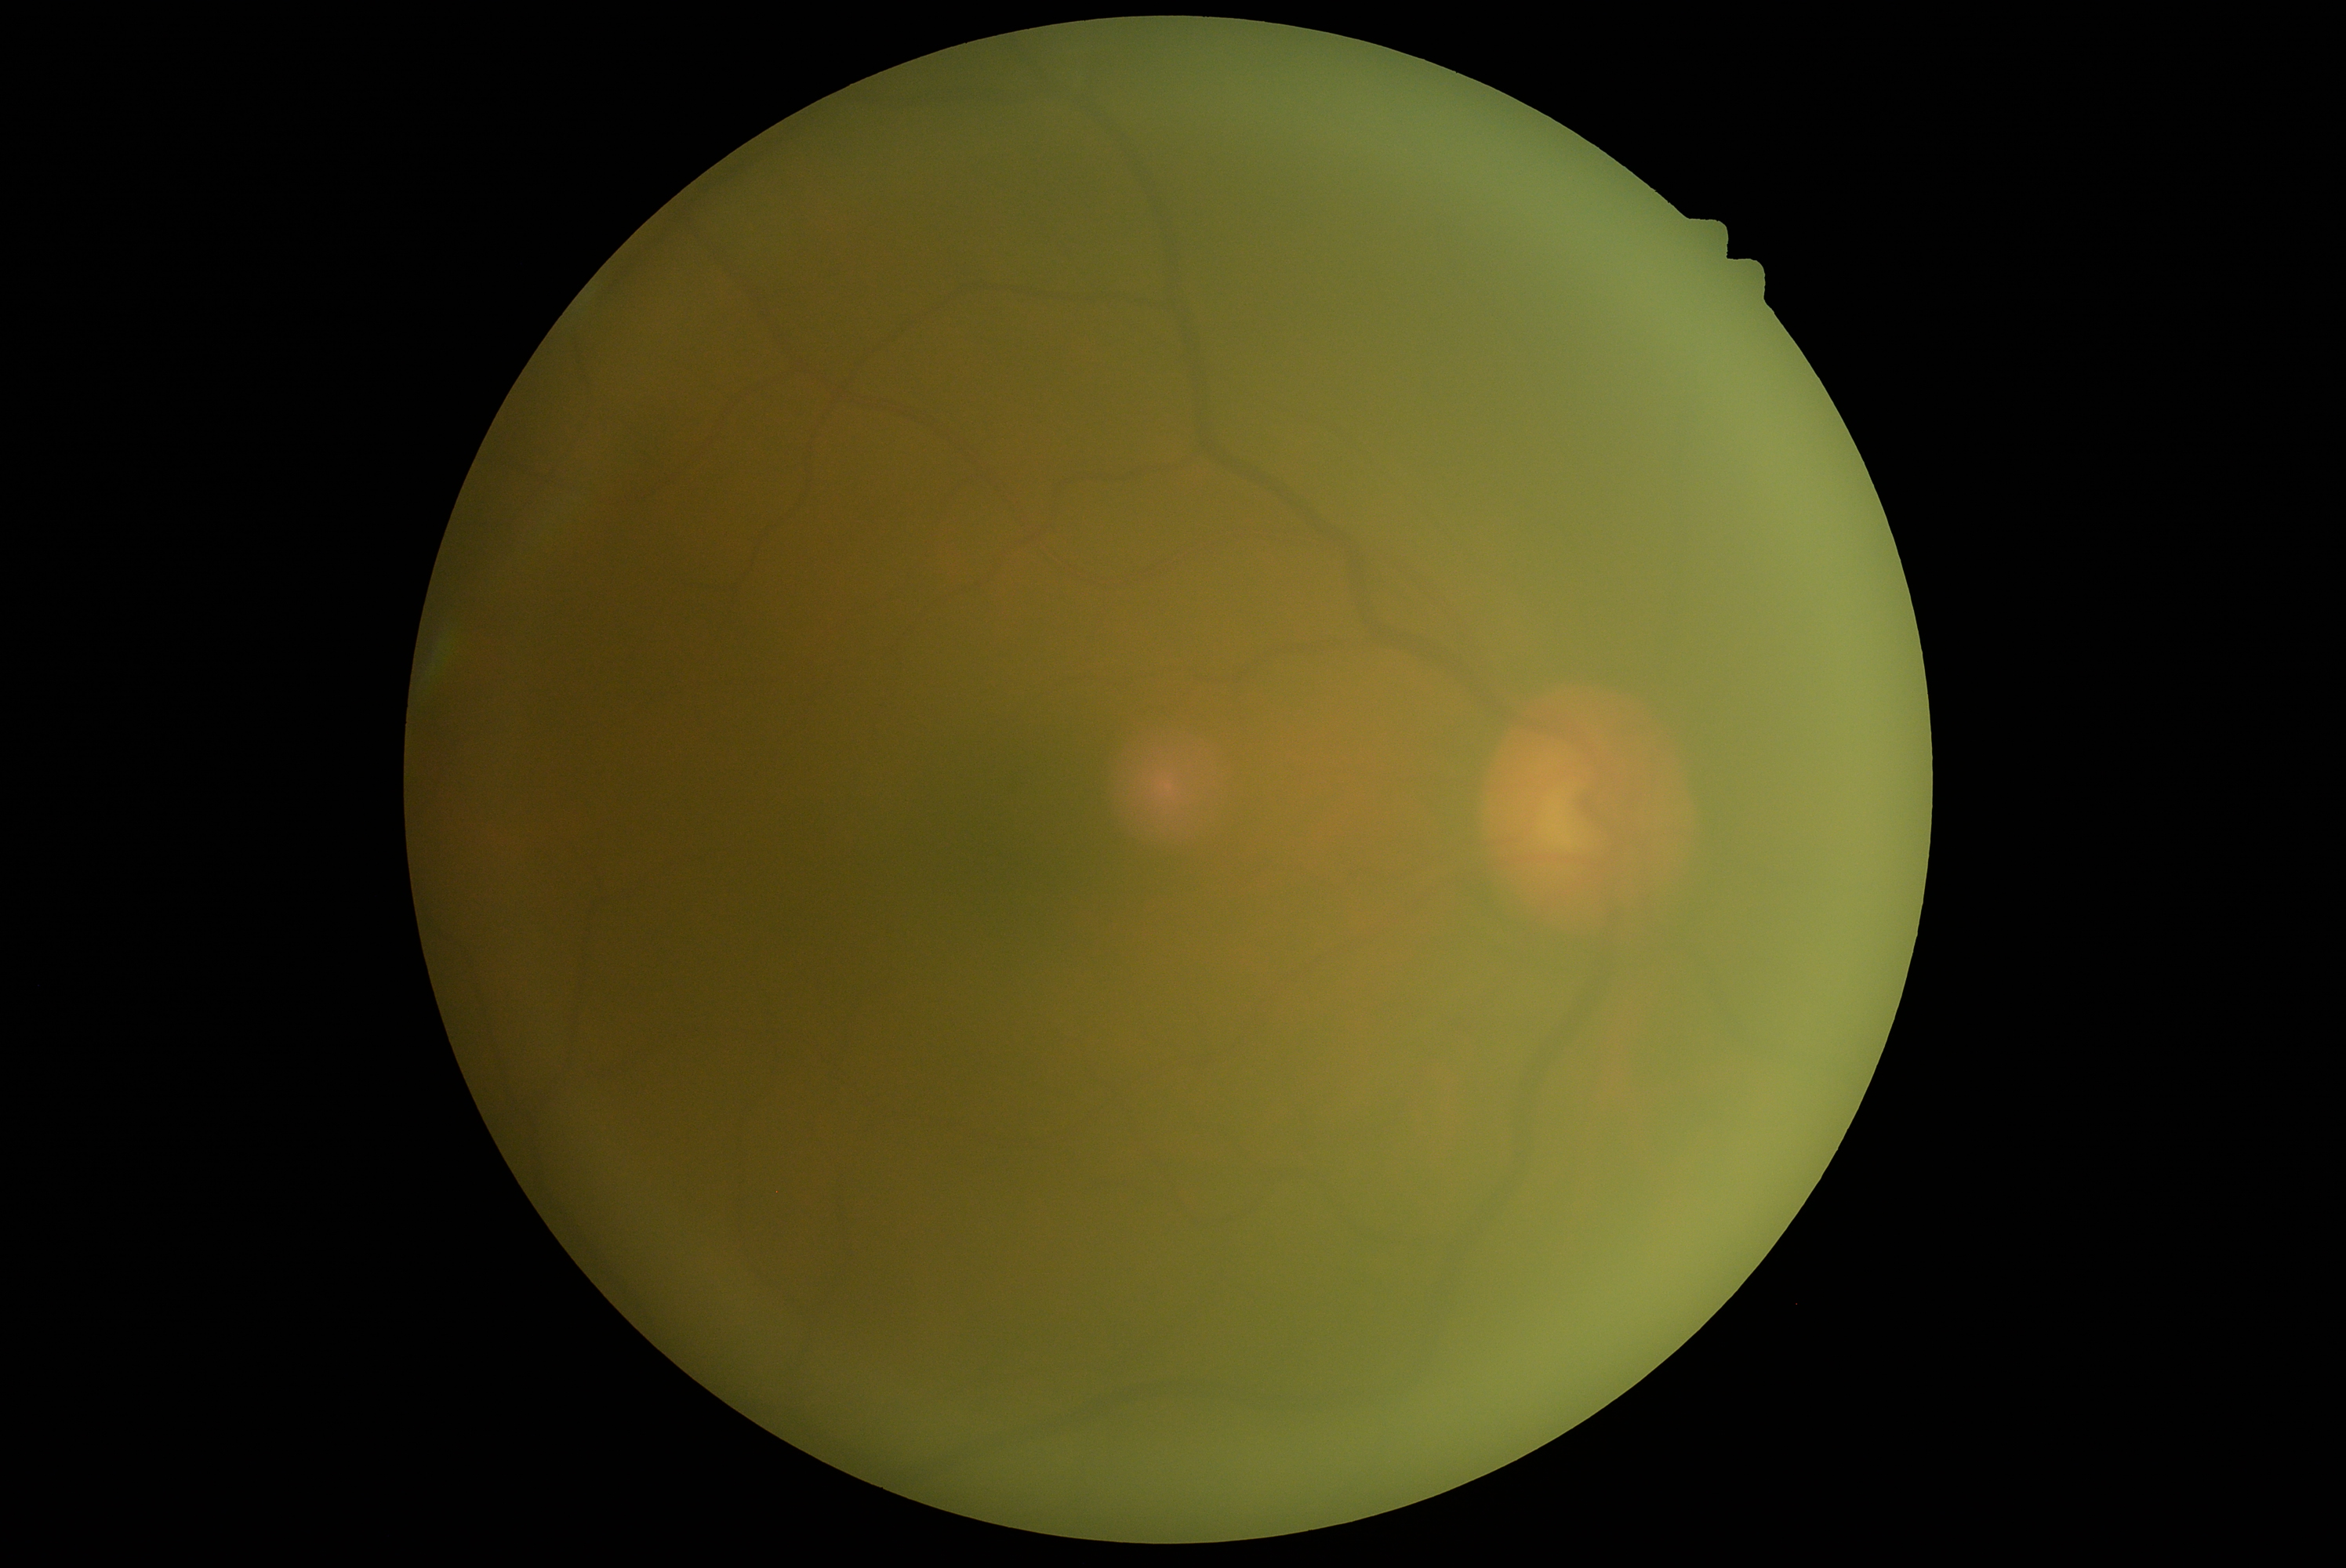
DR = grade 0 (no apparent retinopathy)